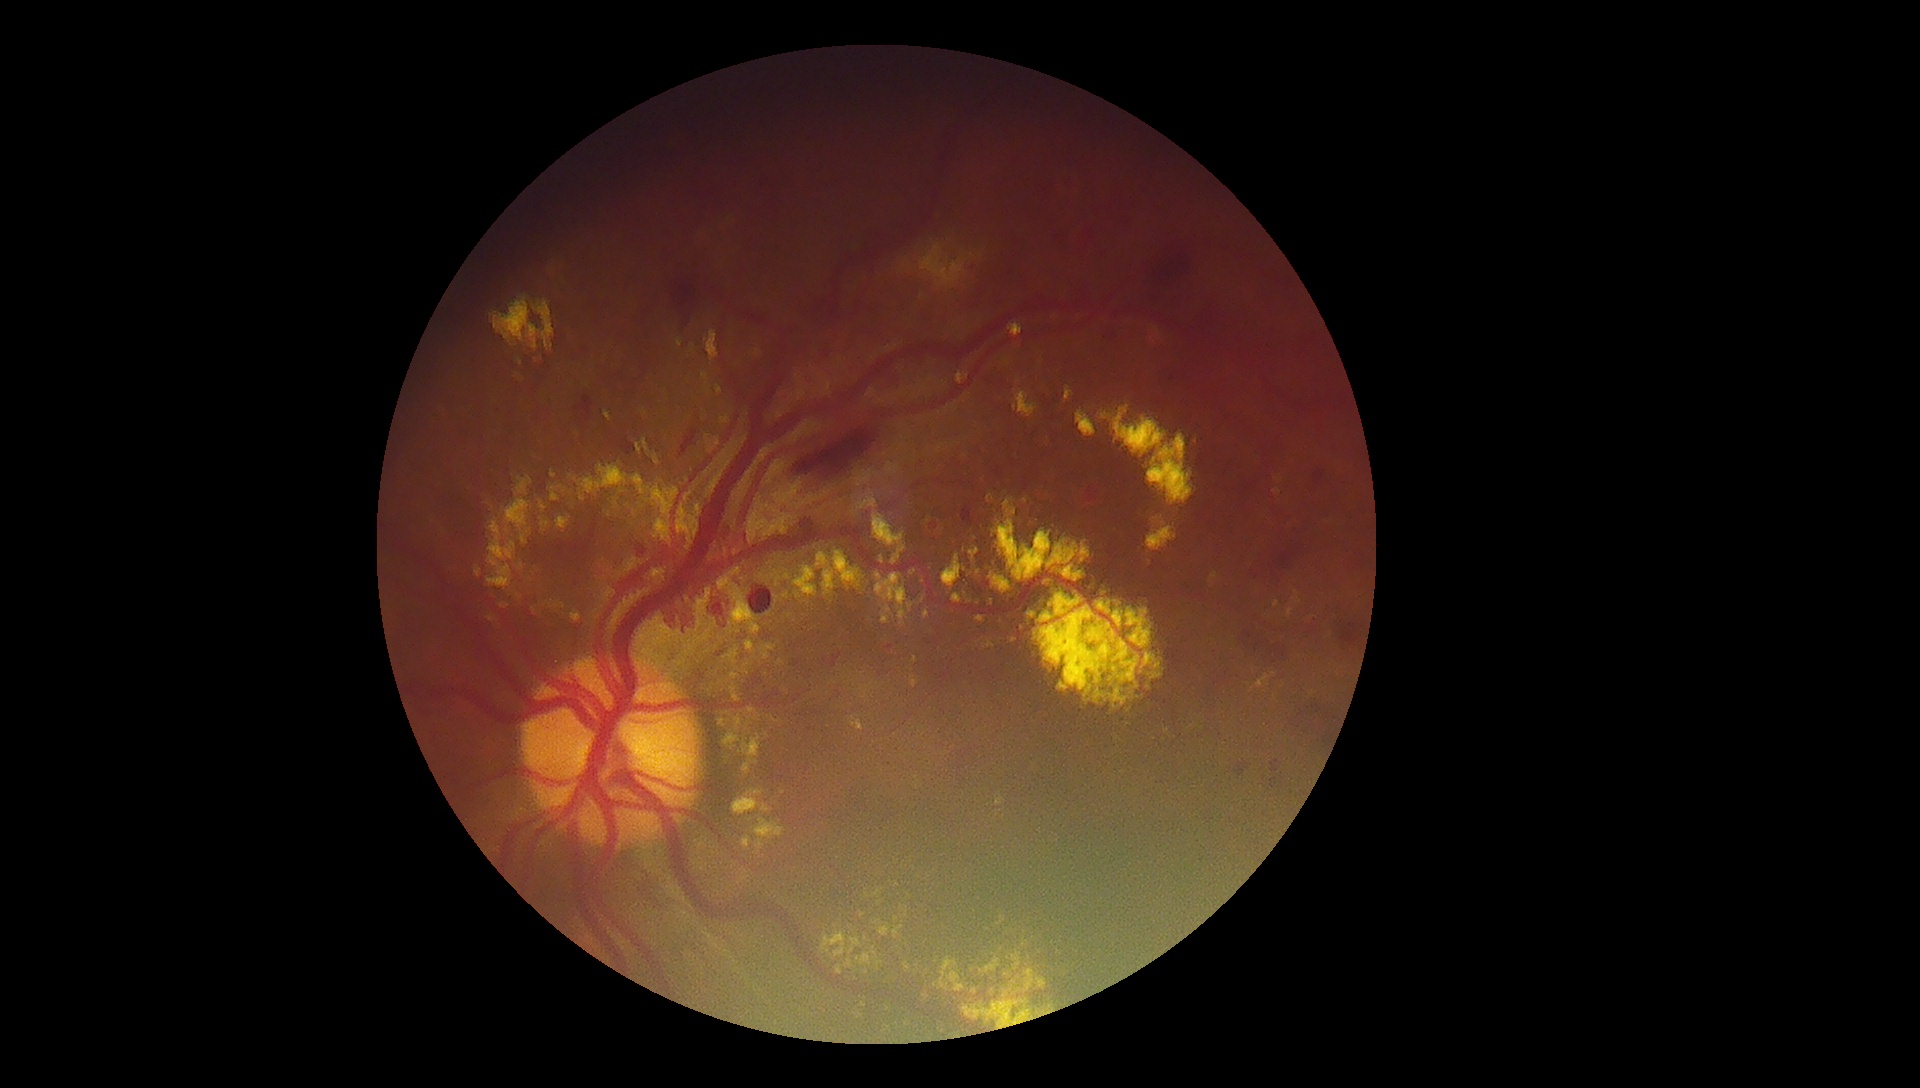
Diabetic retinopathy (DR): grade 4 (PDR); proliferative diabetic retinopathy. Hard exudates (EXs) are present, including at [left=540, top=501, right=547, bottom=513], [left=720, top=414, right=731, bottom=426], [left=685, top=492, right=692, bottom=502], [left=942, top=554, right=962, bottom=592], [left=613, top=502, right=618, bottom=510], [left=694, top=631, right=712, bottom=645], [left=1009, top=323, right=1024, bottom=337], [left=706, top=330, right=719, bottom=361], [left=718, top=576, right=761, bottom=635], [left=742, top=670, right=750, bottom=676], [left=873, top=891, right=881, bottom=898], [left=533, top=301, right=555, bottom=351], [left=970, top=549, right=980, bottom=560]. Small EXs near Point(706, 340), Point(767, 735), Point(897, 885), Point(739, 632), Point(868, 896).